Graded on the modified Davis scale; 848 by 848 pixels: 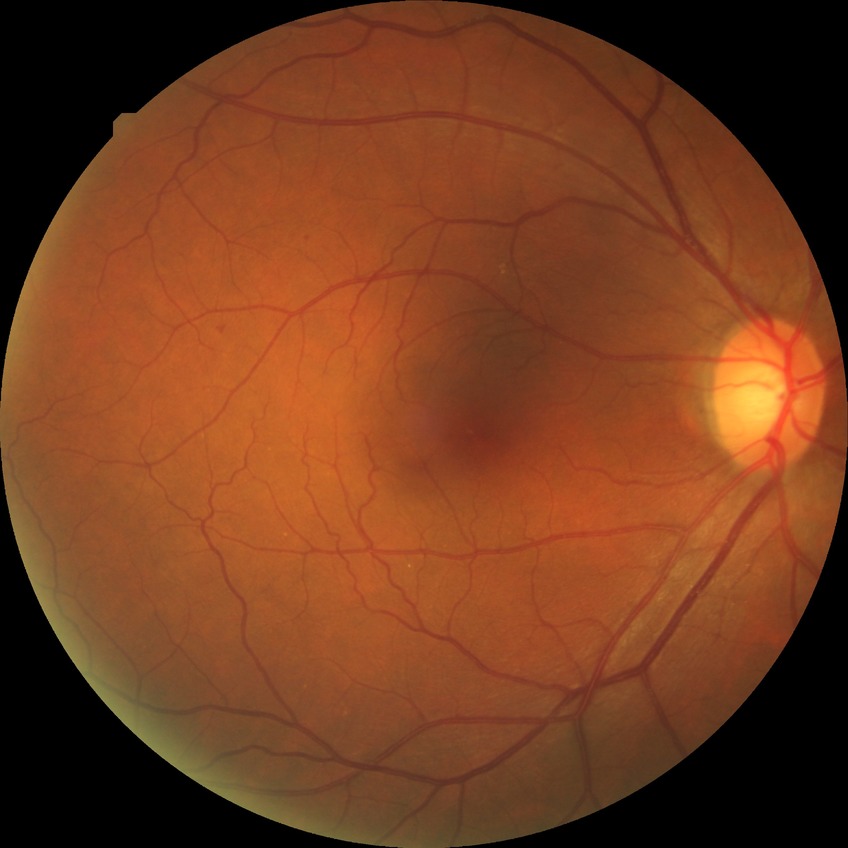
Diabetic retinopathy (DR) is no diabetic retinopathy (NDR).